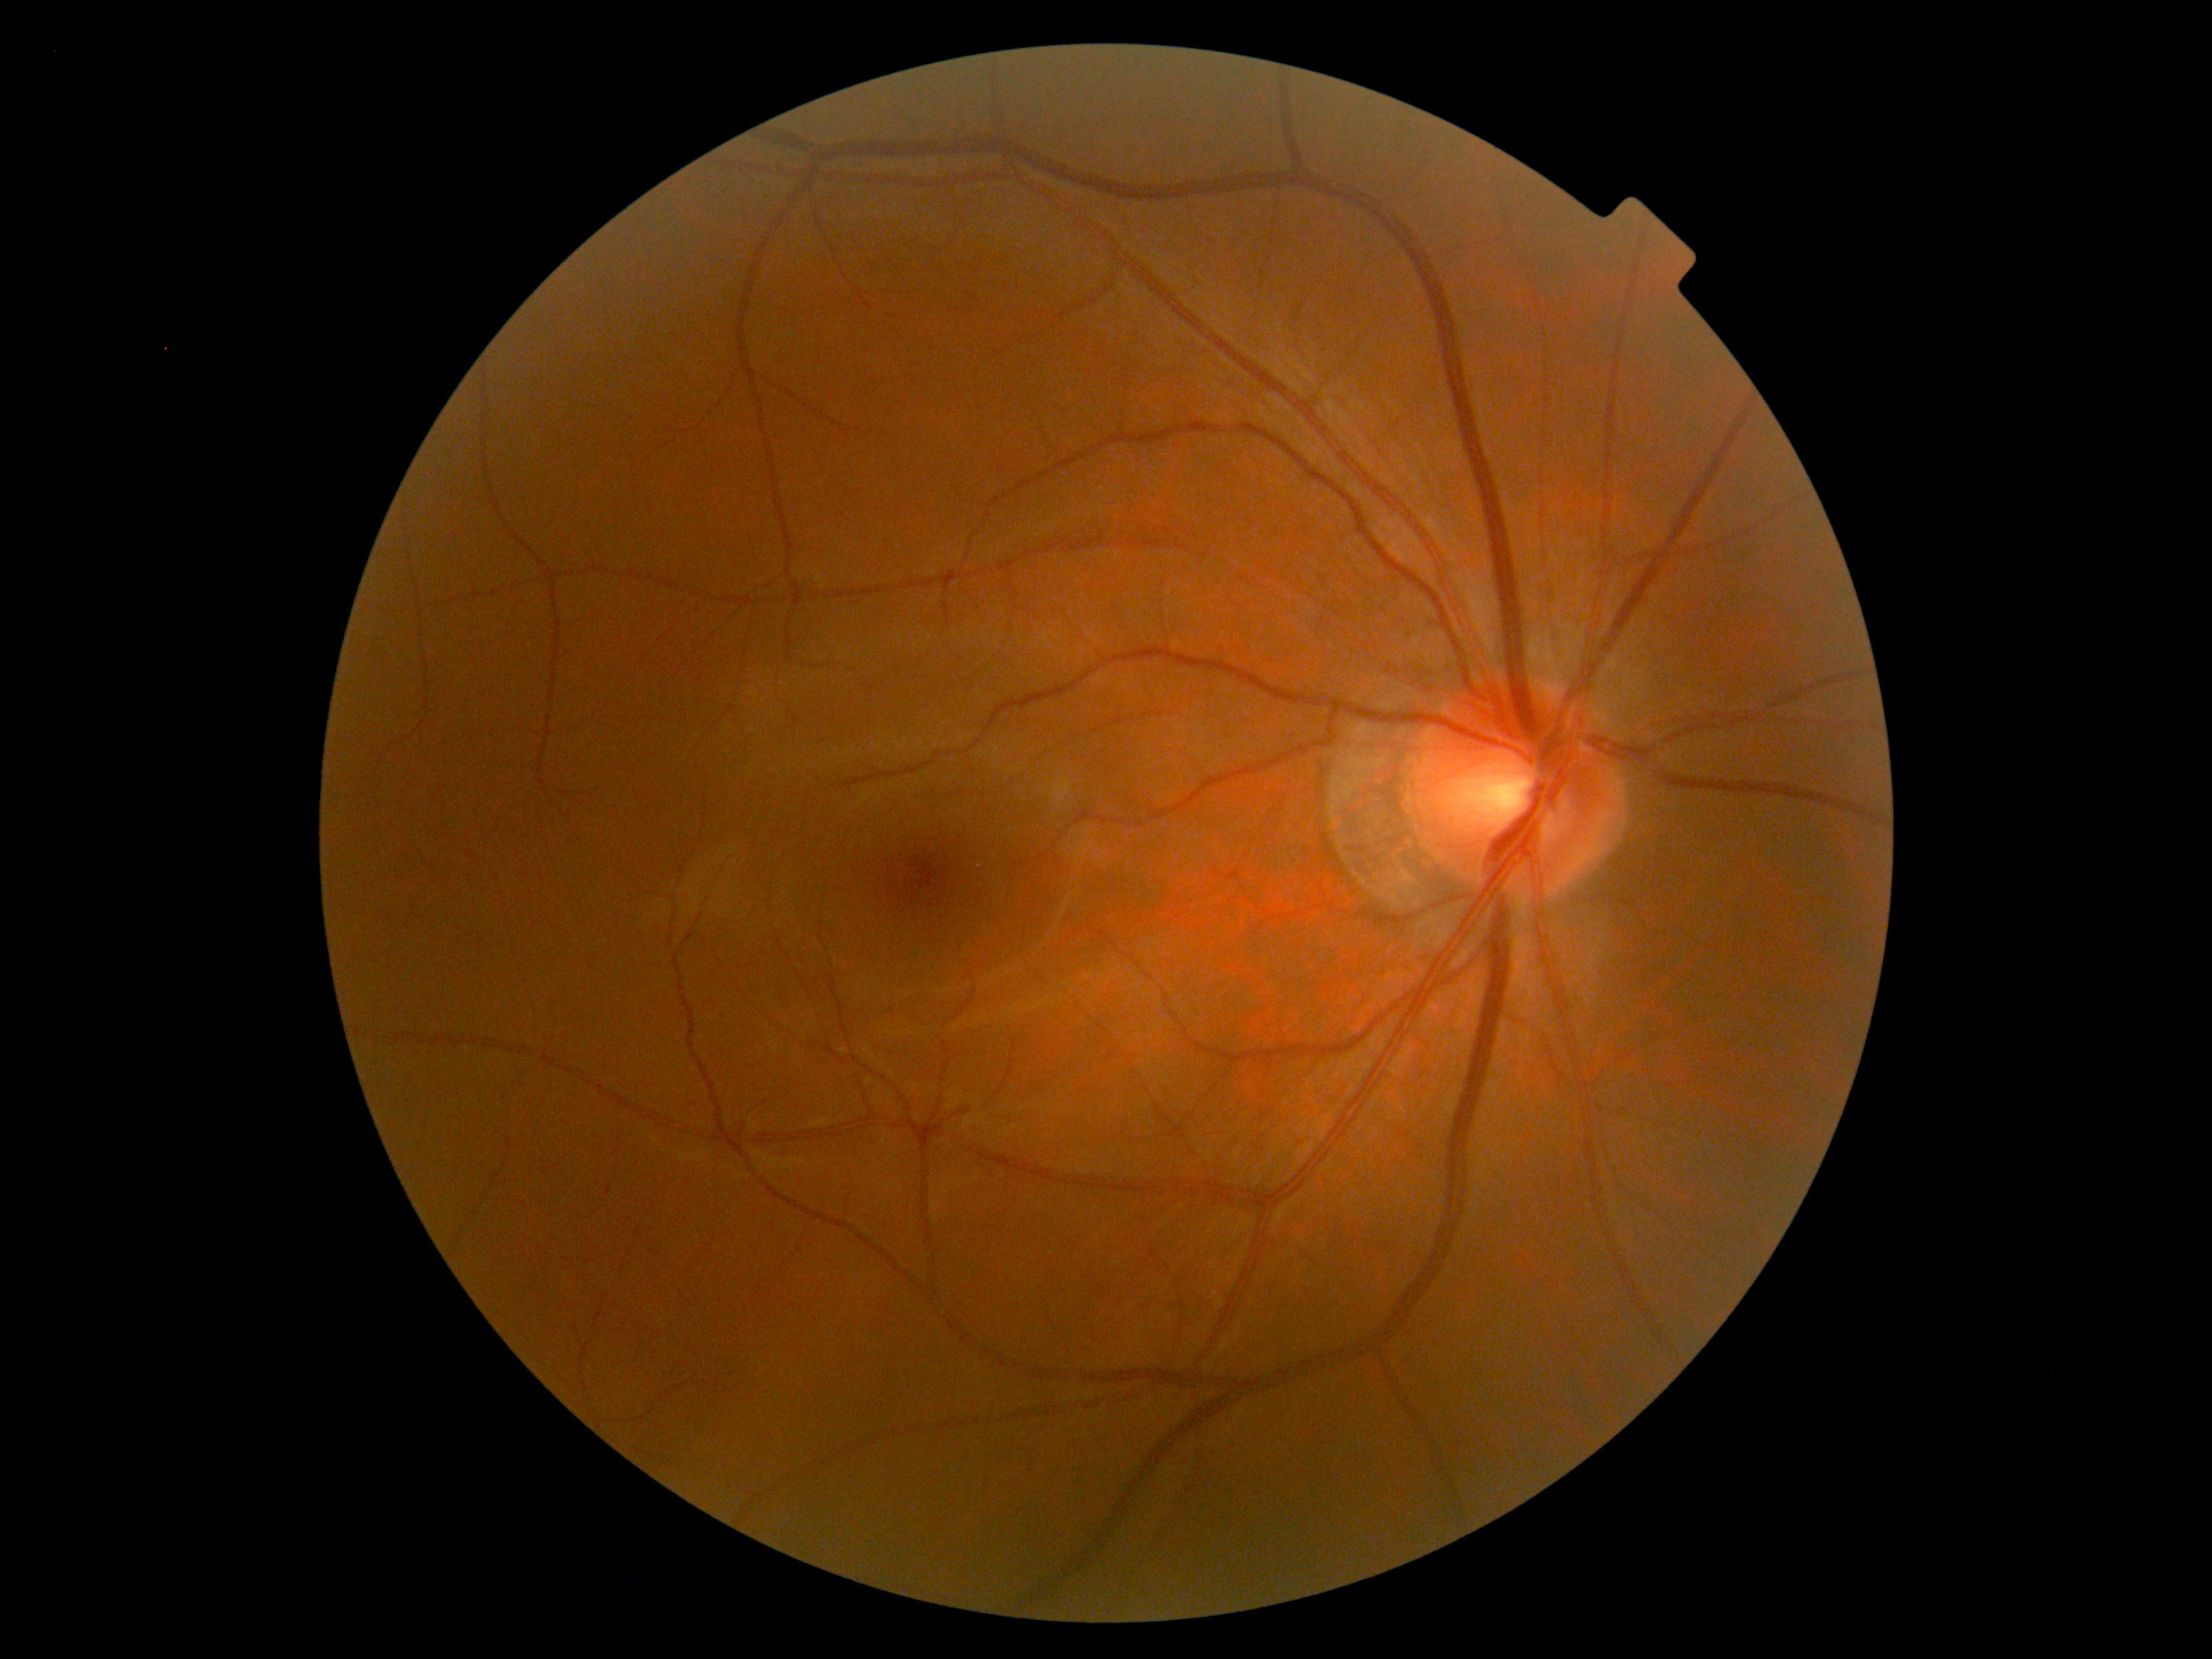 No apparent diabetic retinopathy. DR is grade 0 (no apparent retinopathy).